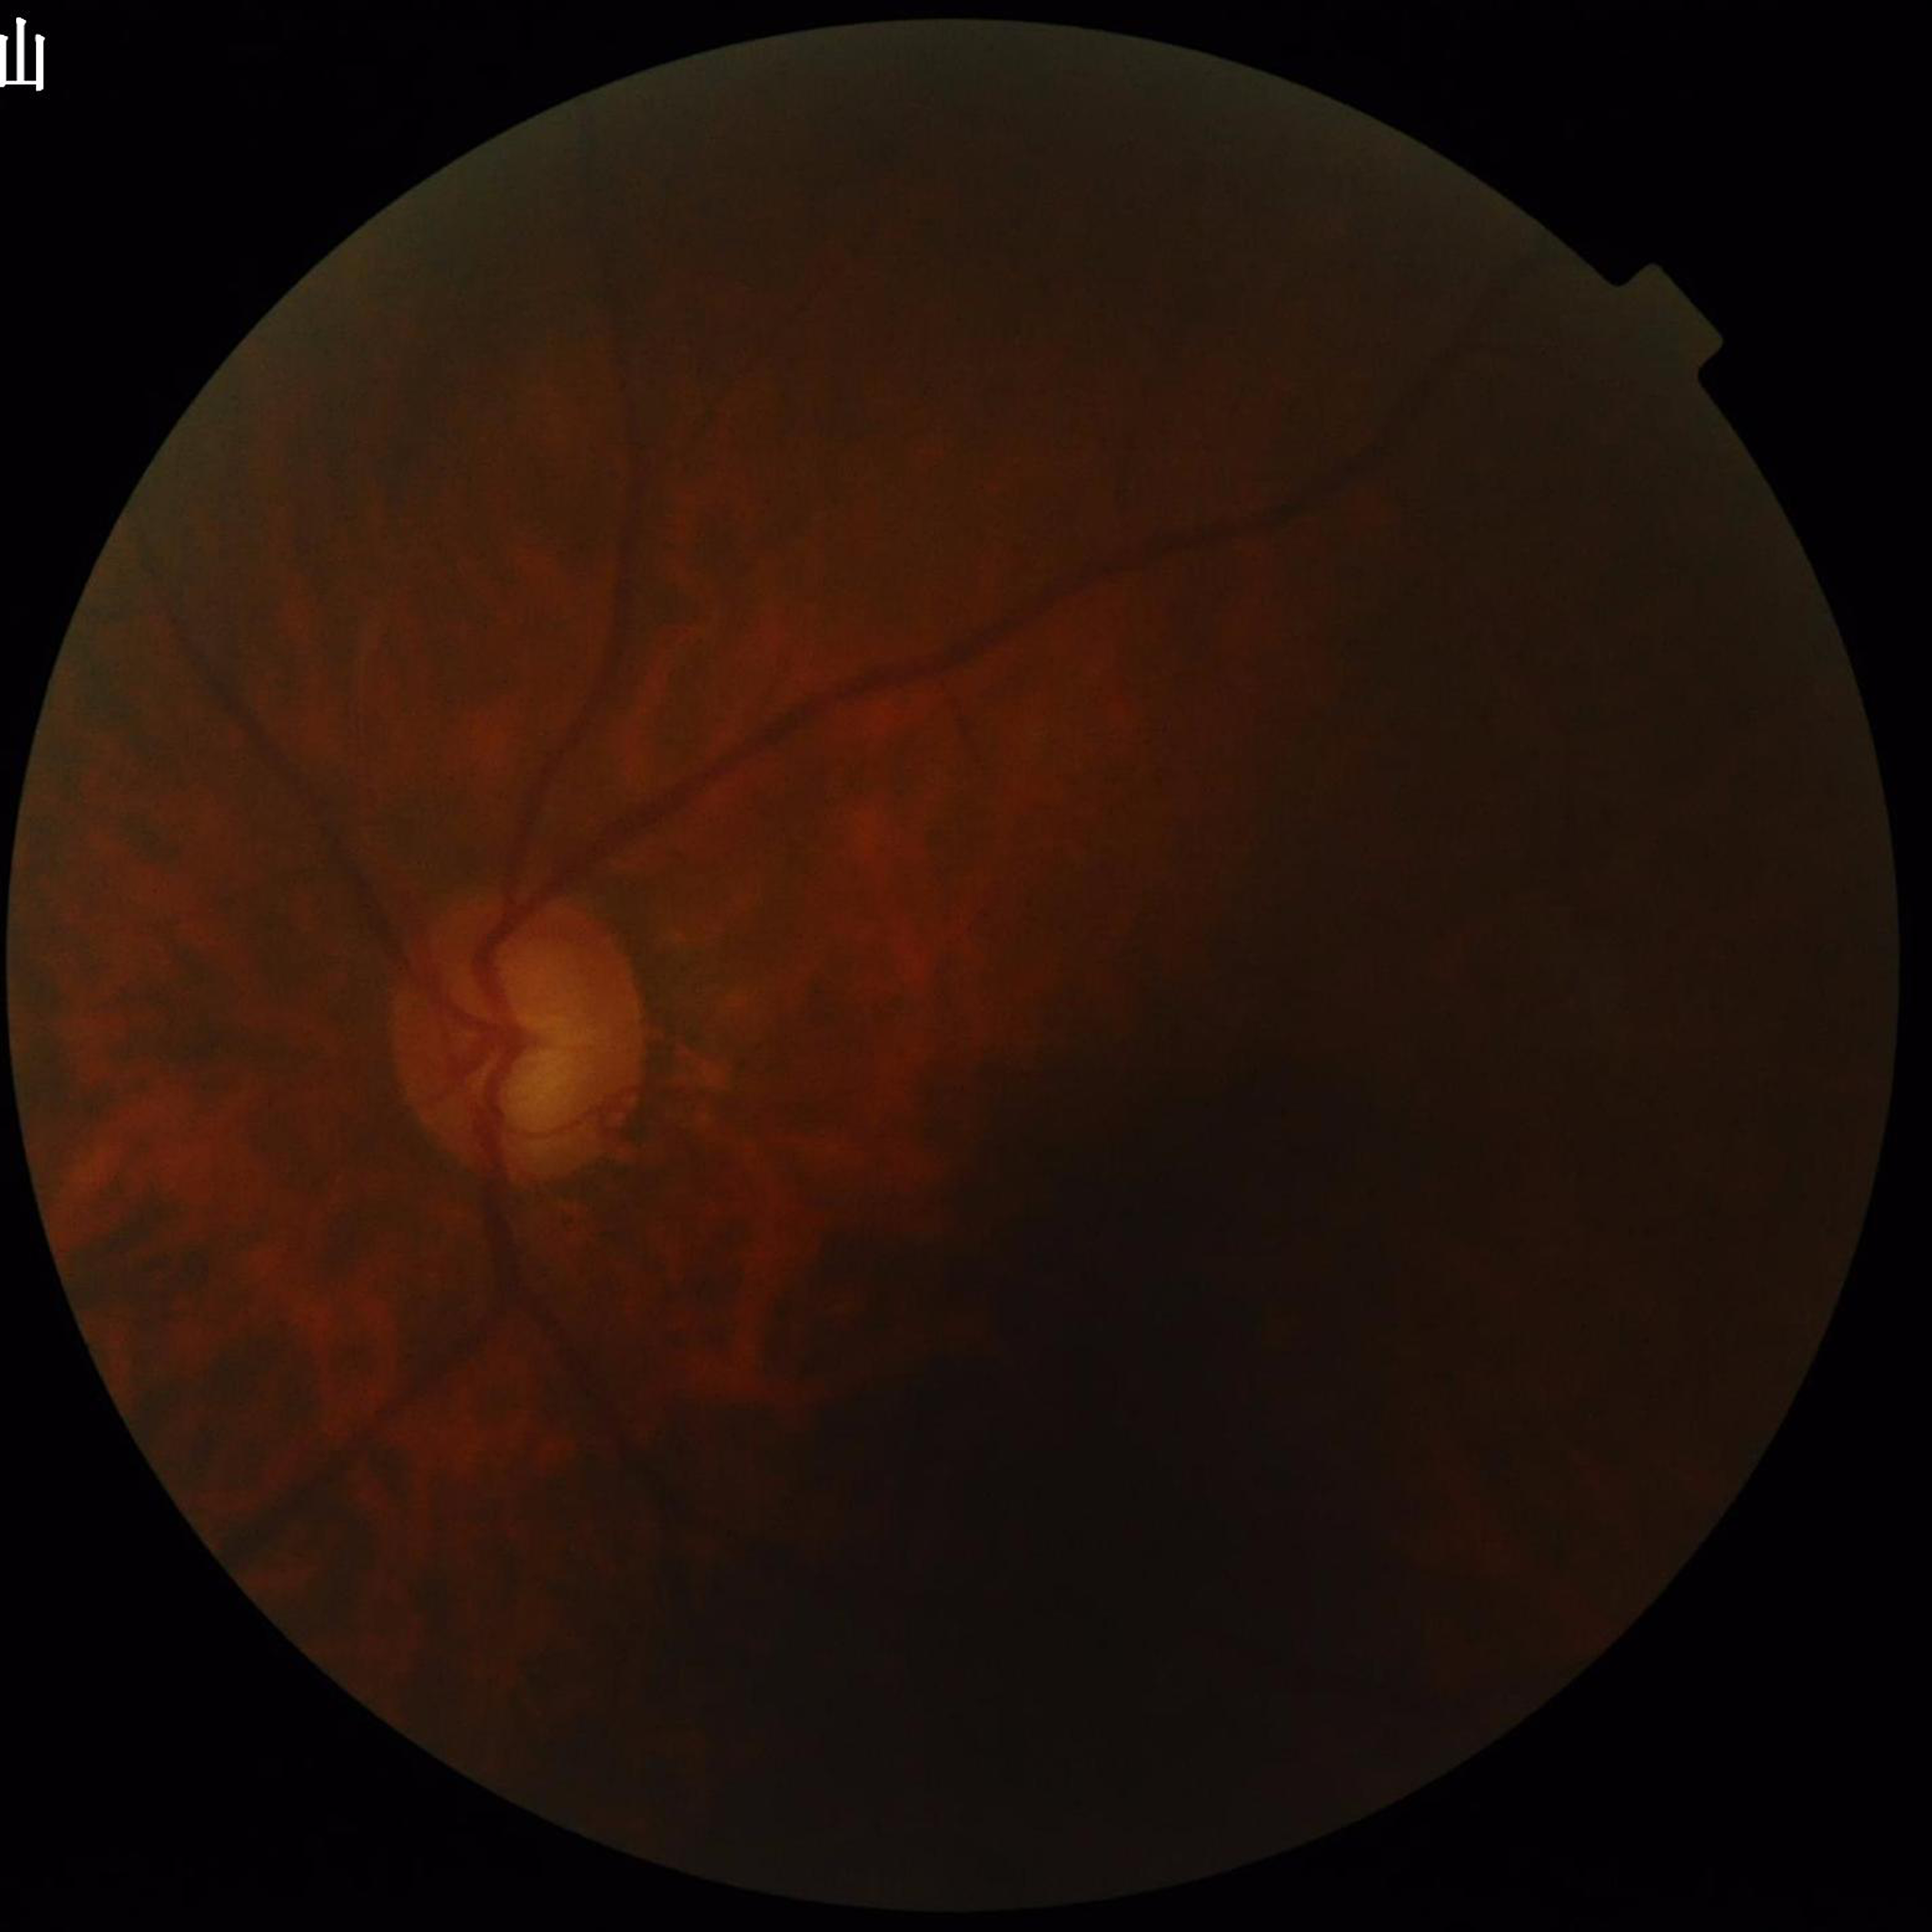
Image quality: suboptimal — blur, illumination/color distortion, low contrast. Color fundus photograph from a patient diagnosed with glaucoma.